Image size 1240x1240; acquired on the Phoenix ICON; wide-field fundus photograph of an infant.
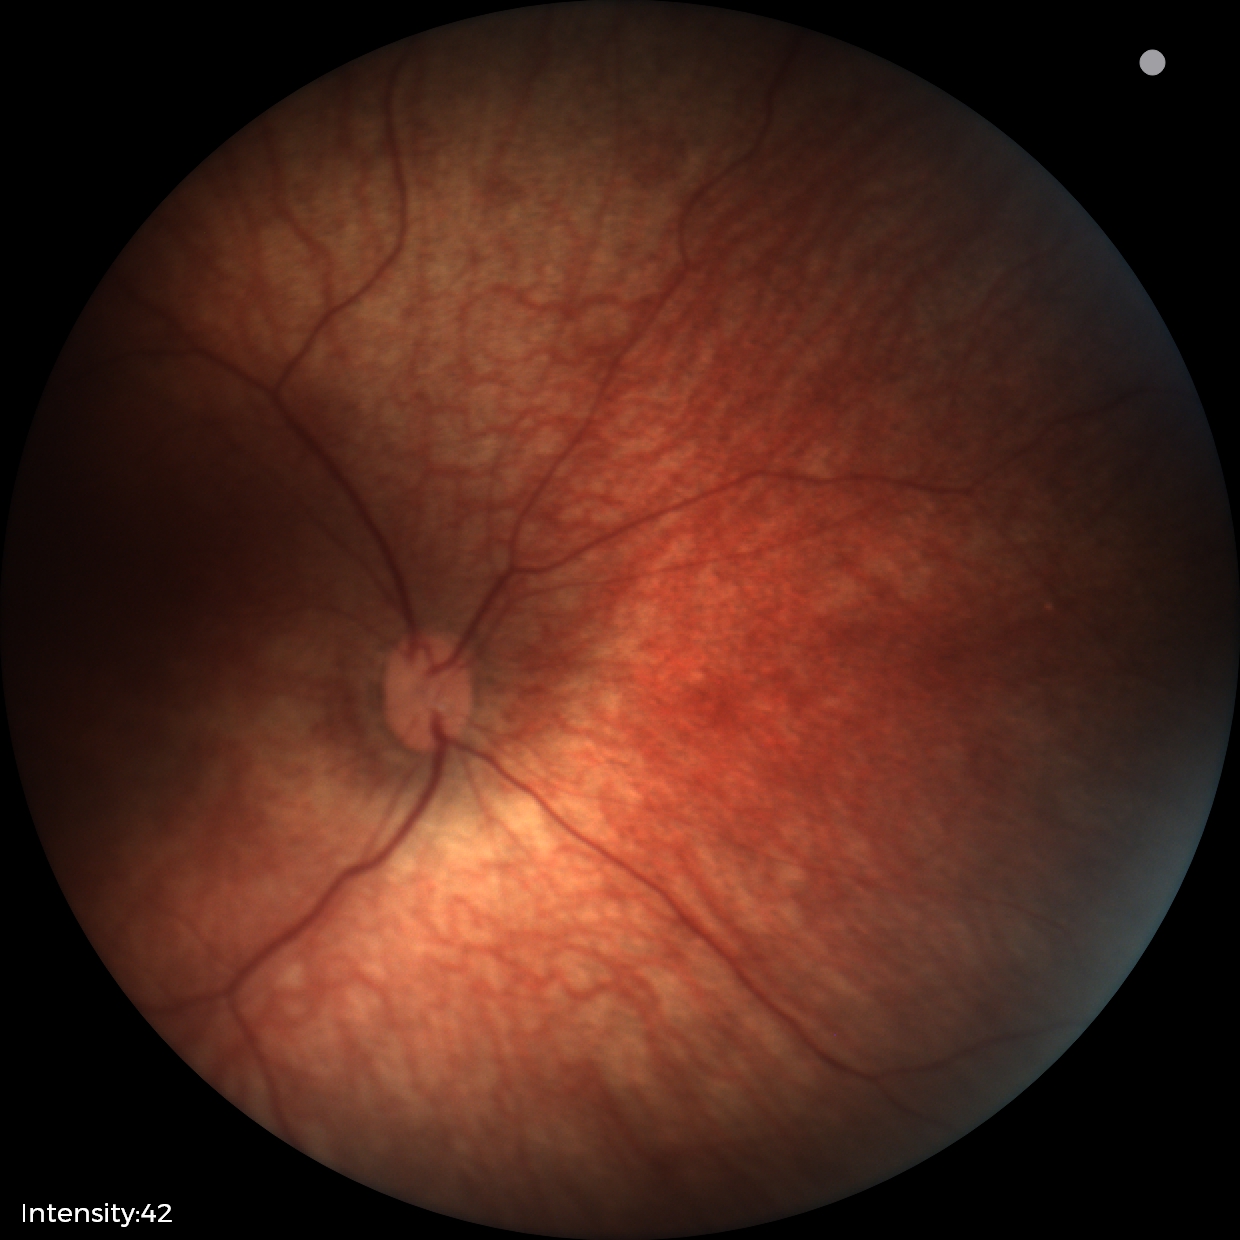 Q: What is the diagnosis from this examination?
A: normal fundus examination